Color fundus photograph: 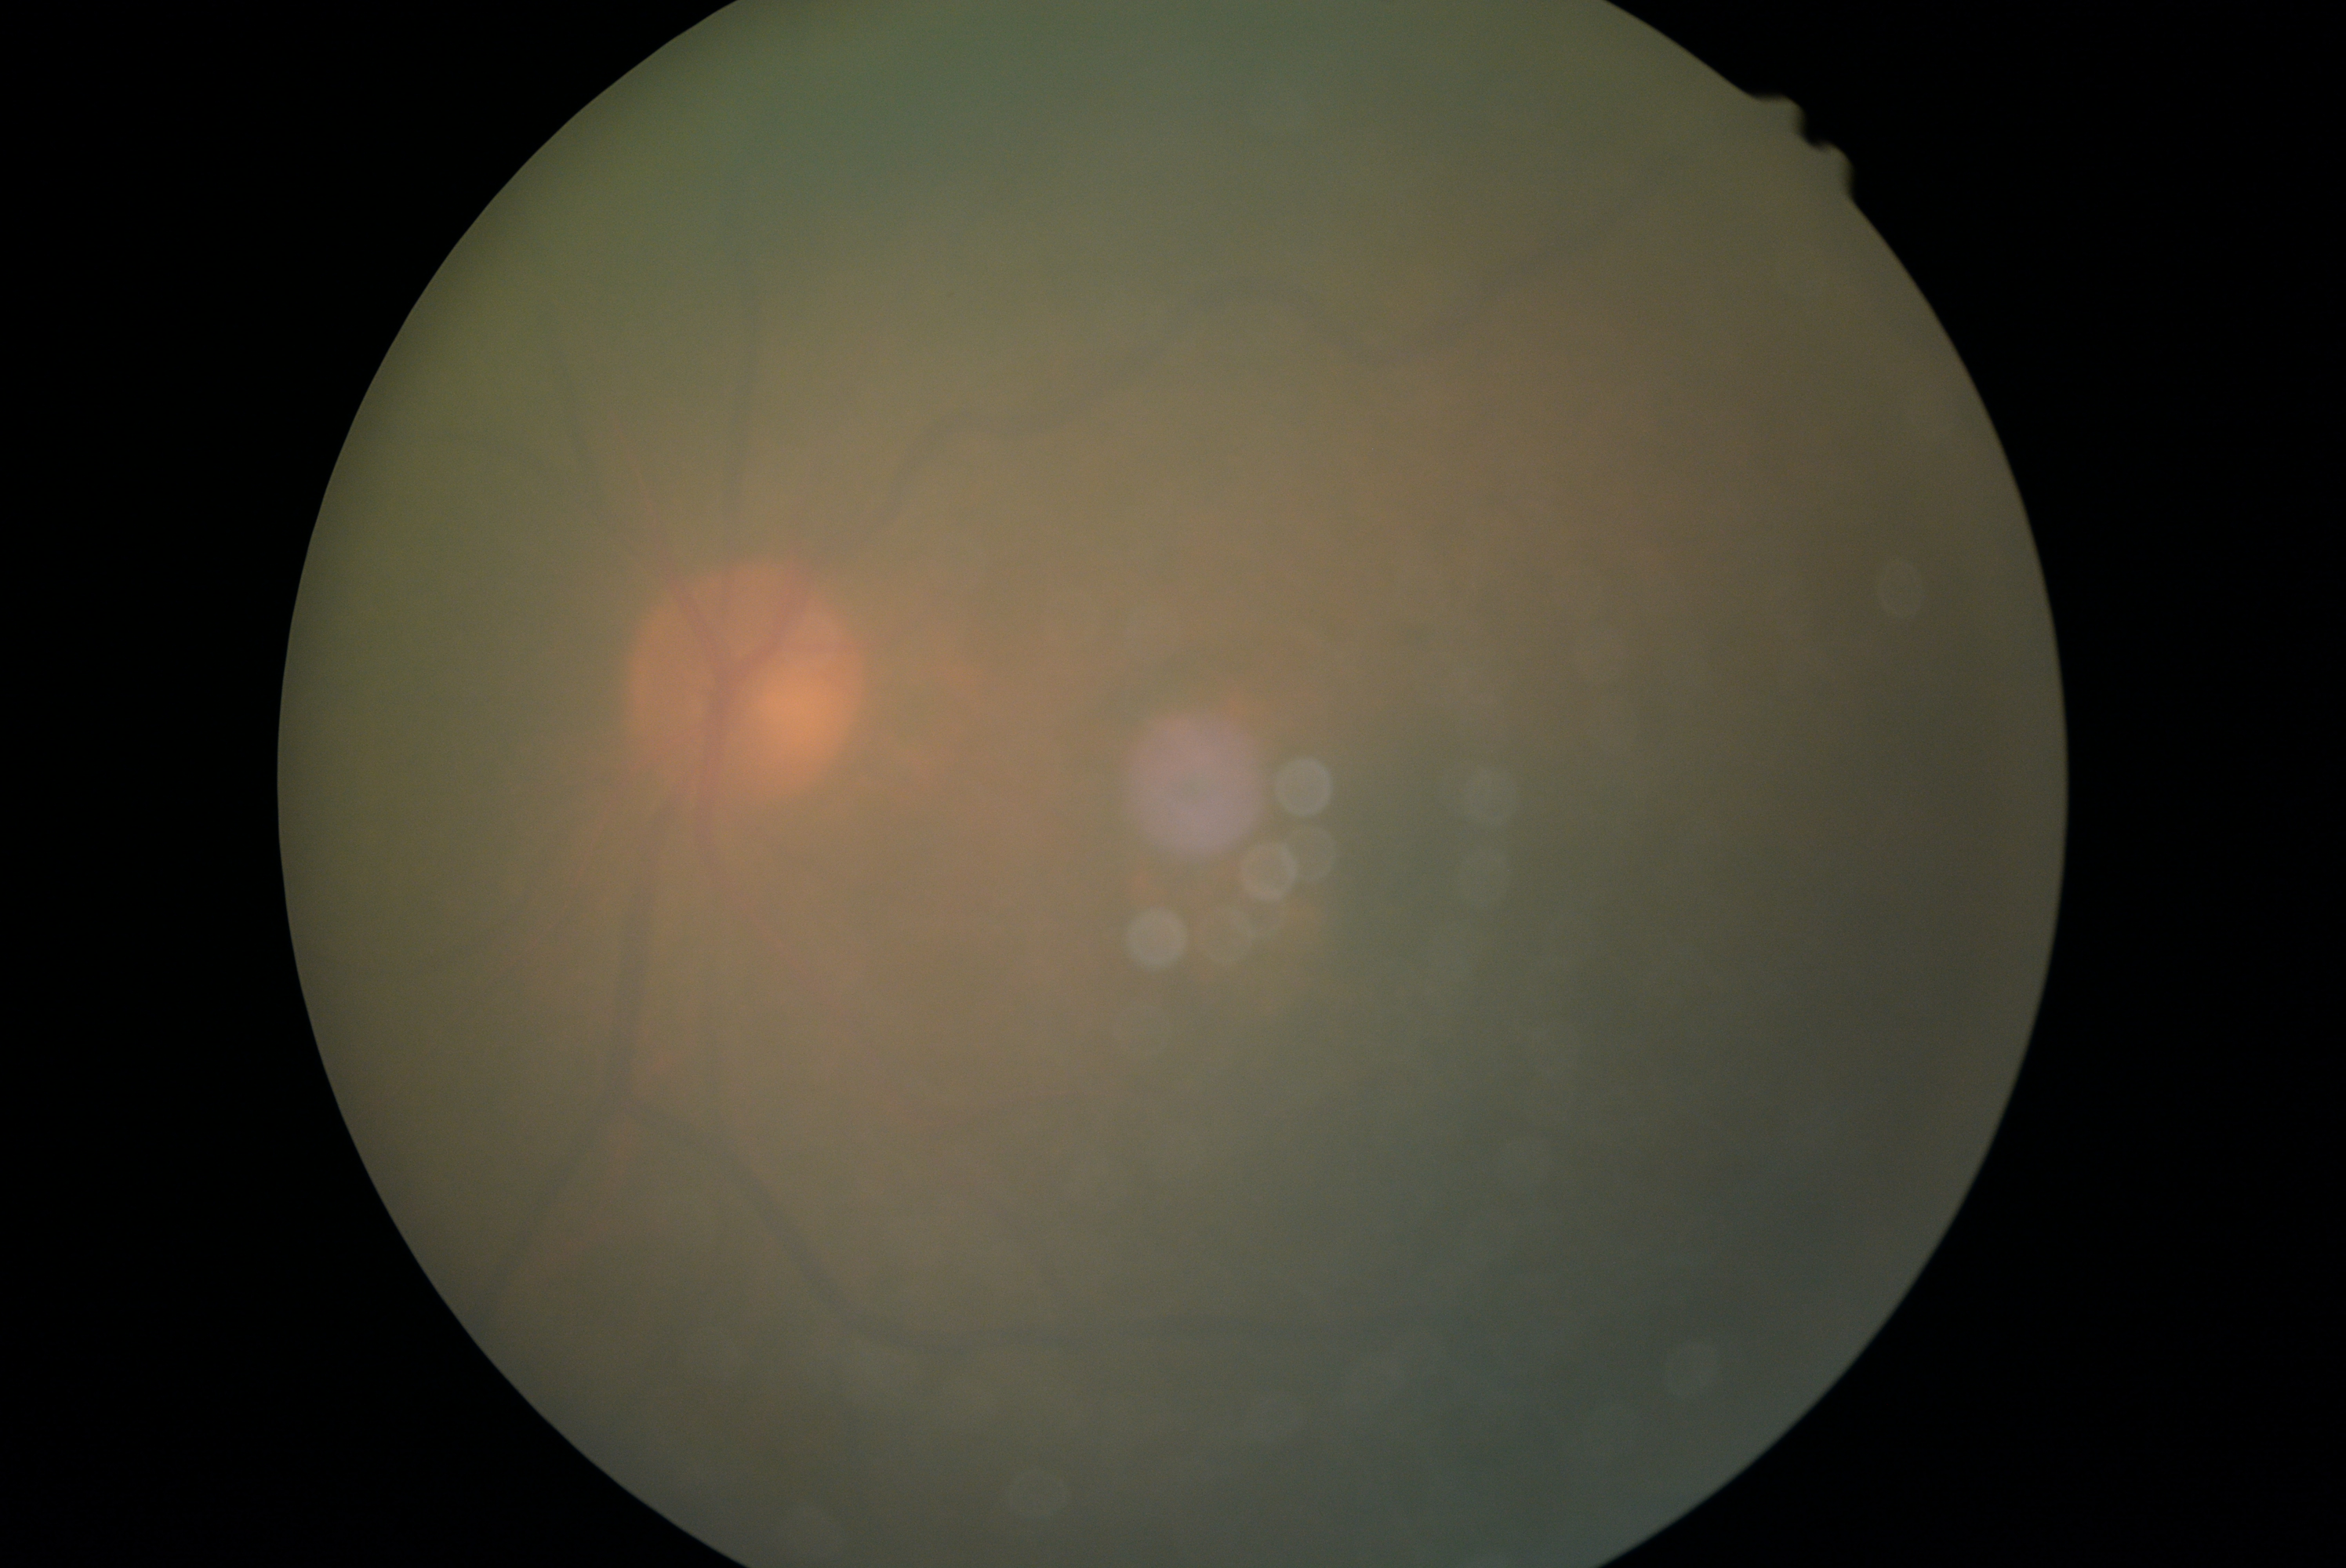 Ungradable image — DR severity cannot be determined.
Diabetic retinopathy grade: ungradable.